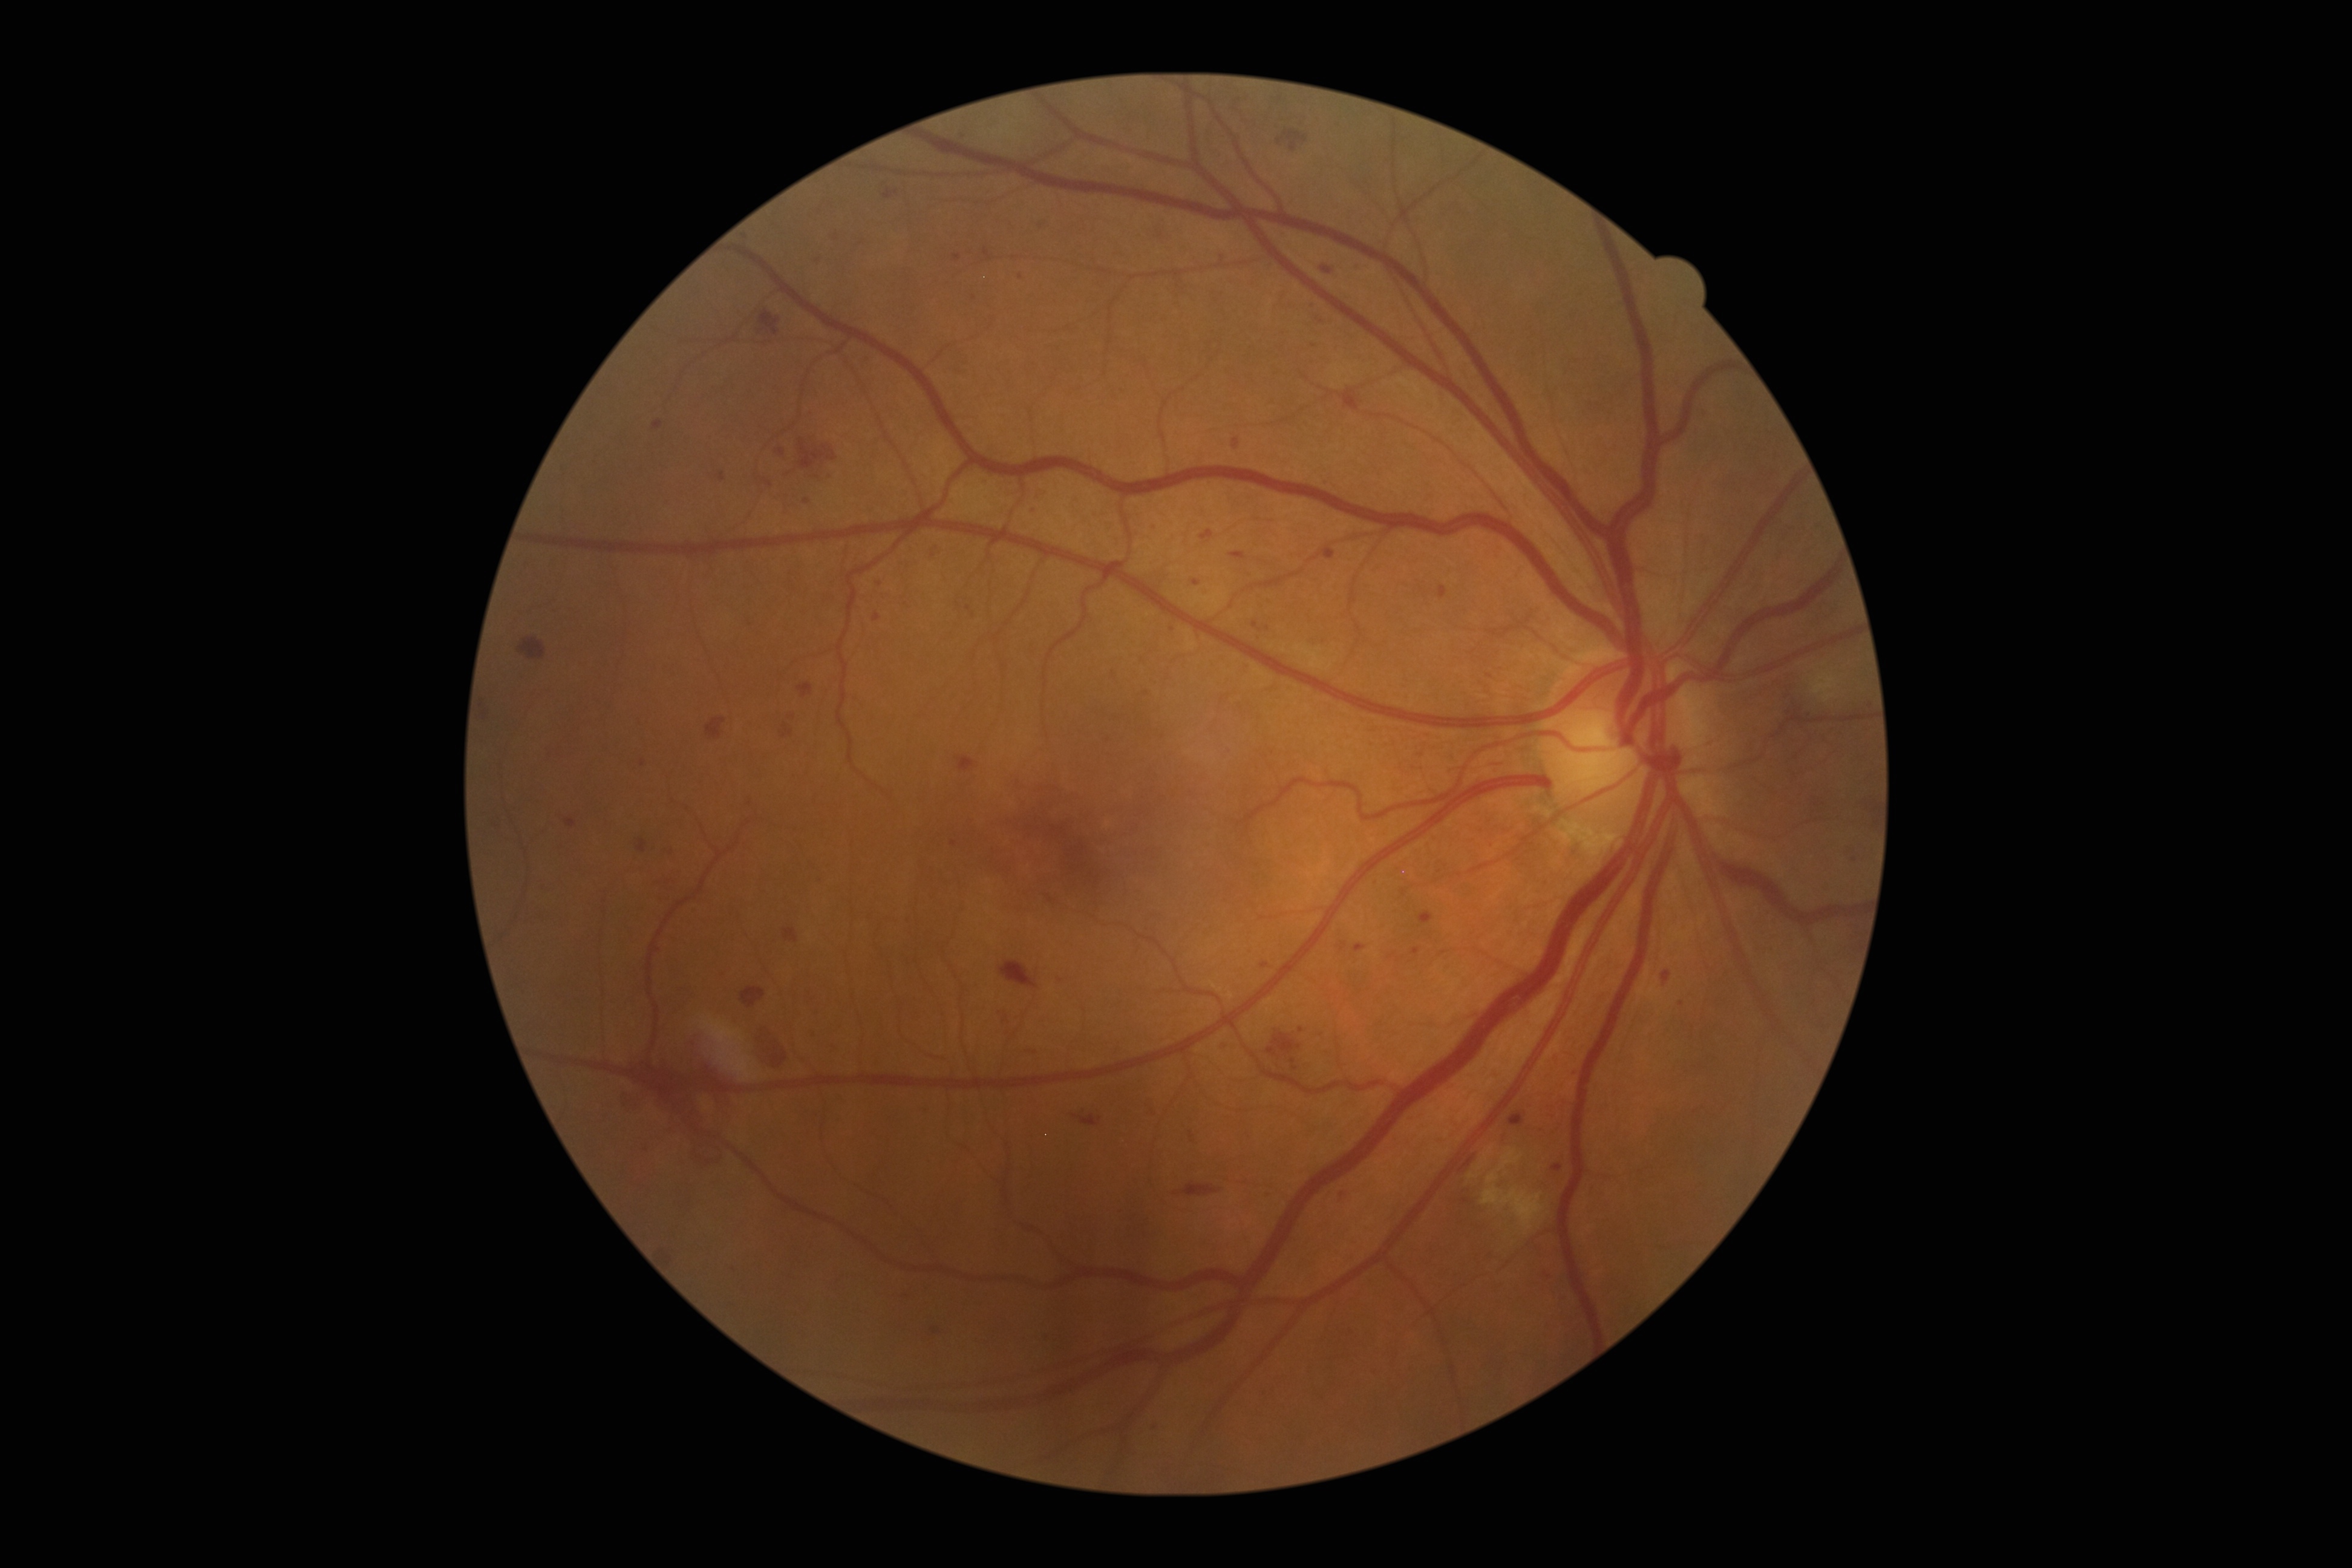

Diabetic retinopathy (DR): severe non-proliferative diabetic retinopathy (grade 3) — more than 20 intraretinal hemorrhages in each of 4 quadrants, definite venous beading in 2 or more quadrants, or prominent intraretinal microvascular abnormalities in 1 or more quadrants, with no signs of proliferative retinopathy
Selected lesions:
microaneurysms (MAs) (partial) = 718,472,725,482; 958,757,977,773; 1311,305,1321,312; 1439,585,1448,598; 1419,752,1428,760; 1486,1256,1496,1266; 1420,910,1433,924; 874,613,880,621; 1335,1190,1346,1203
MAs (small, approximate centers) near (1006,1019); (955,842); (974,297); (807,502); (1682,1003); (1855,860); (1392,956); (1574,1073)